Camera: Nidek AFC-330: 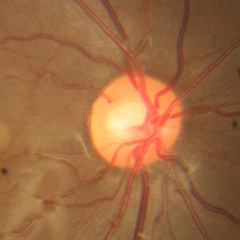
No evidence of glaucoma.